CFP, 45° field of view:
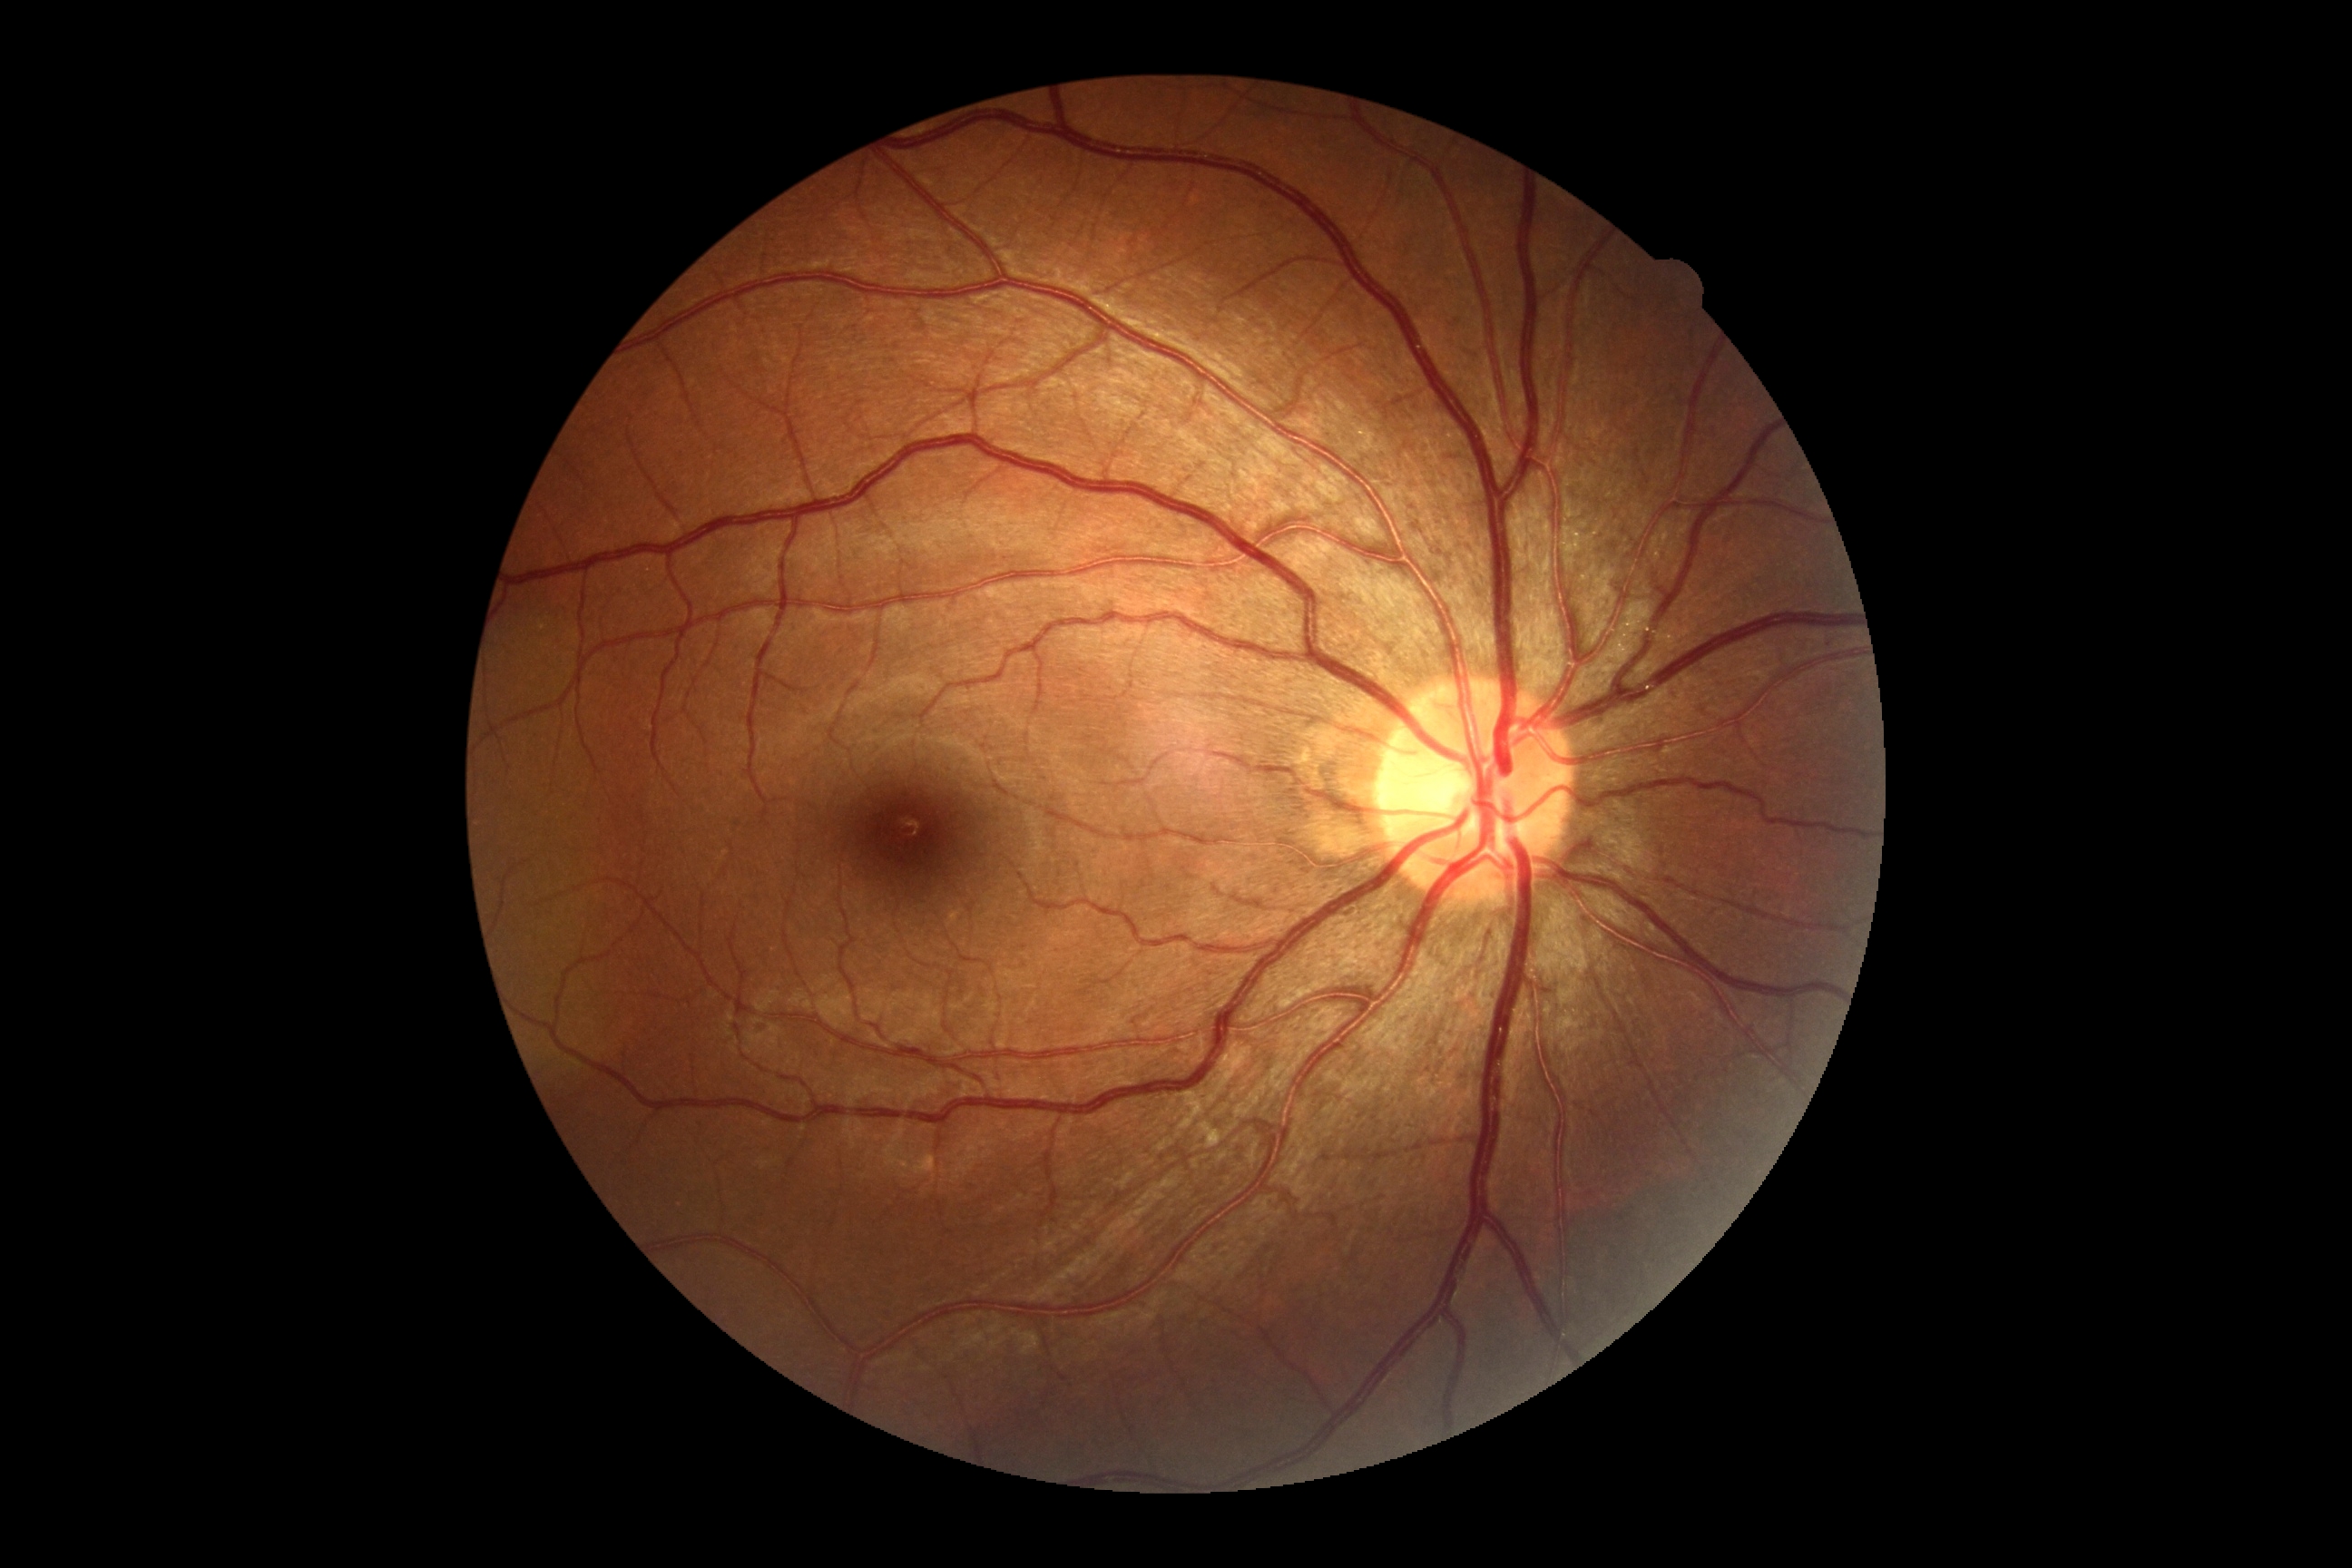 No signs of diabetic retinopathy. DR grade: no apparent retinopathy (0).